1240x1240px. Pediatric wide-field fundus photograph.
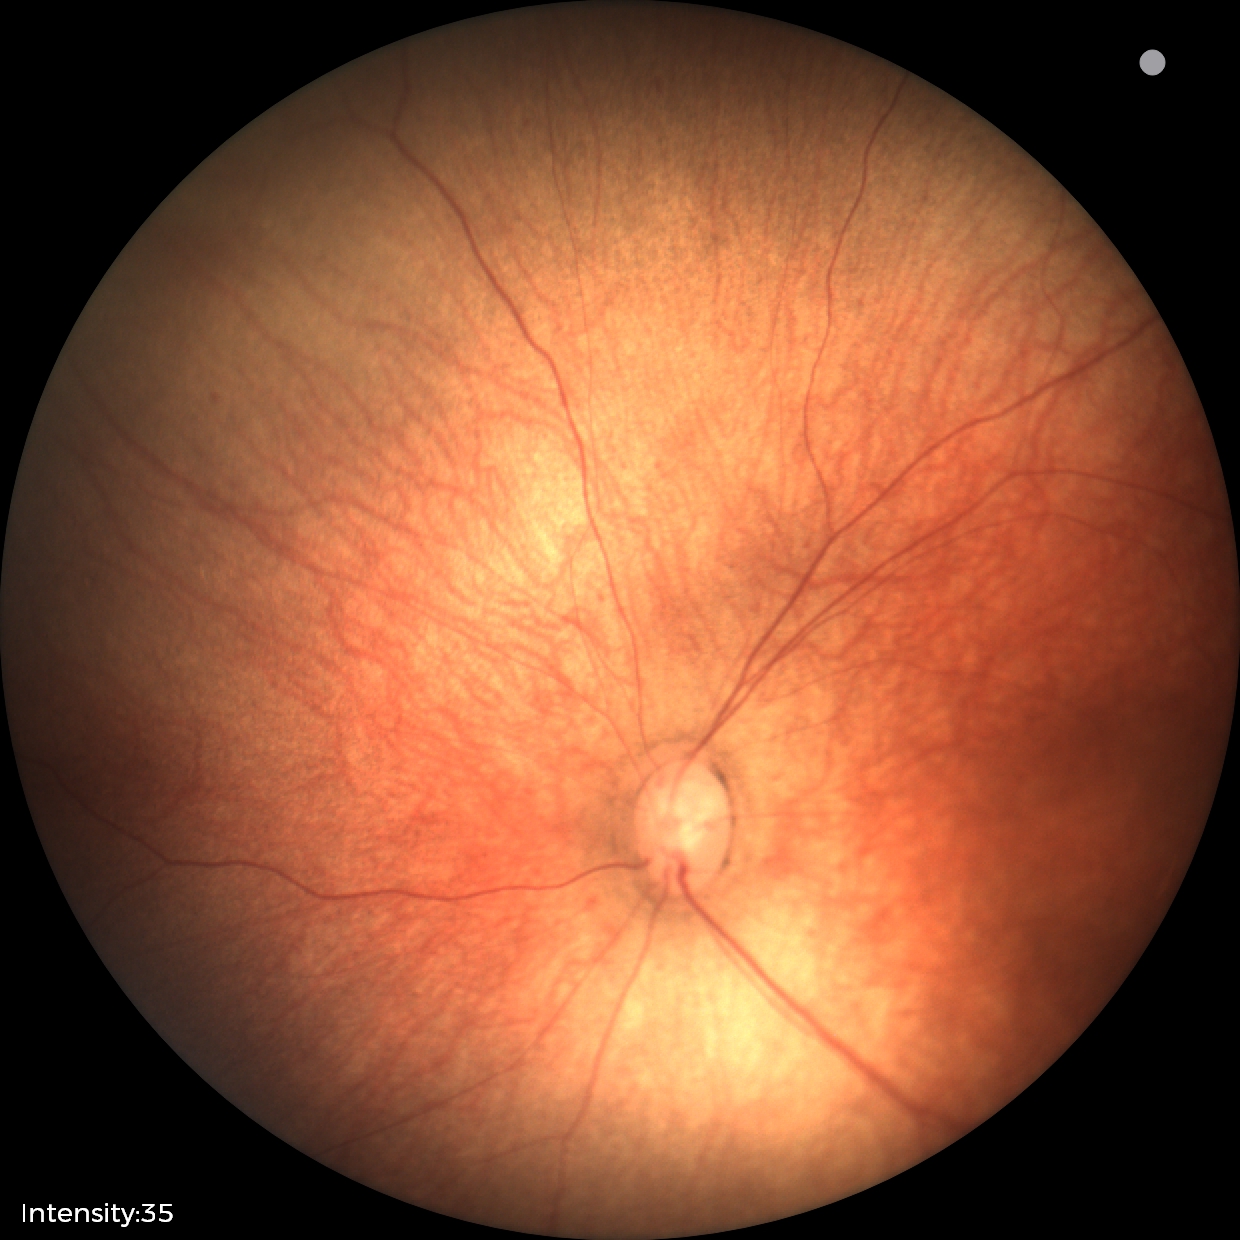

Screening examination with no abnormal retinal findings.